NIDEK AFC-230 fundus camera · 45-degree field of view.
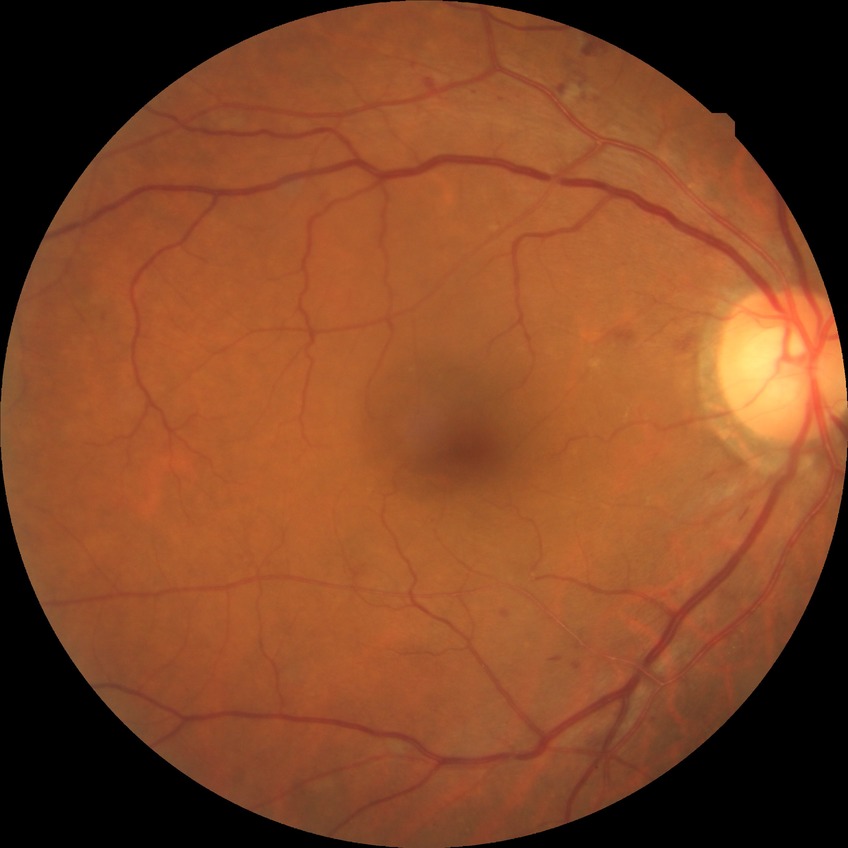 diabetic retinopathy grade: pre-proliferative diabetic retinopathy.